UWF retinal mosaic.
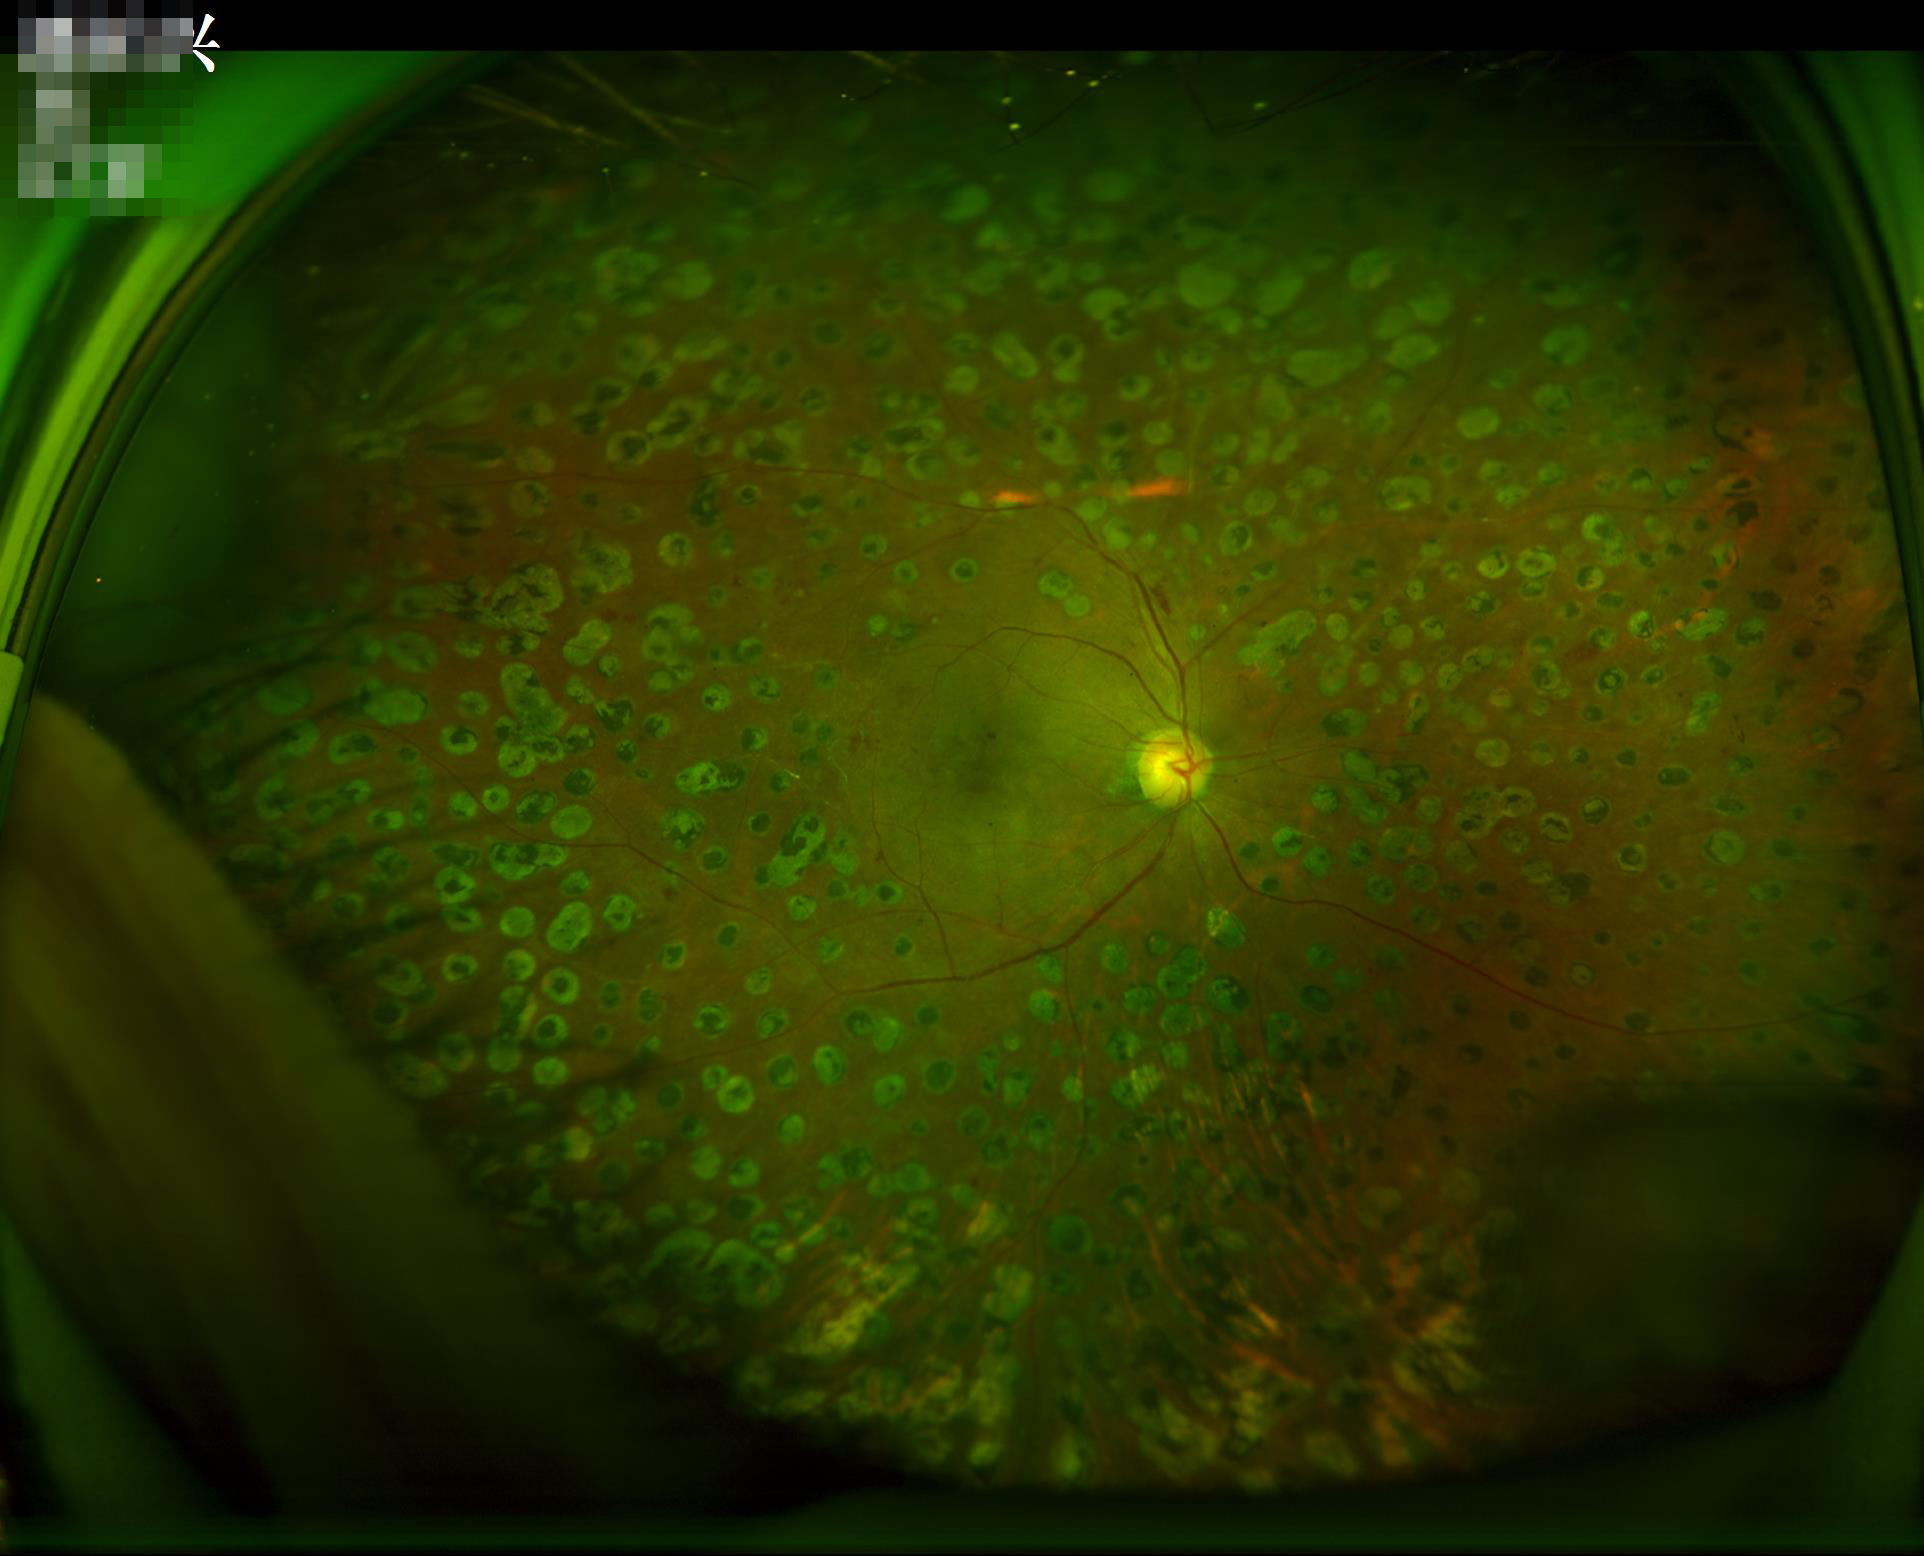
Focus: clear with no noticeable blur; Illumination: uniform, no color cast; Overall: adequate for clinical interpretation.